2352 x 1568 pixels · 45-degree field of view
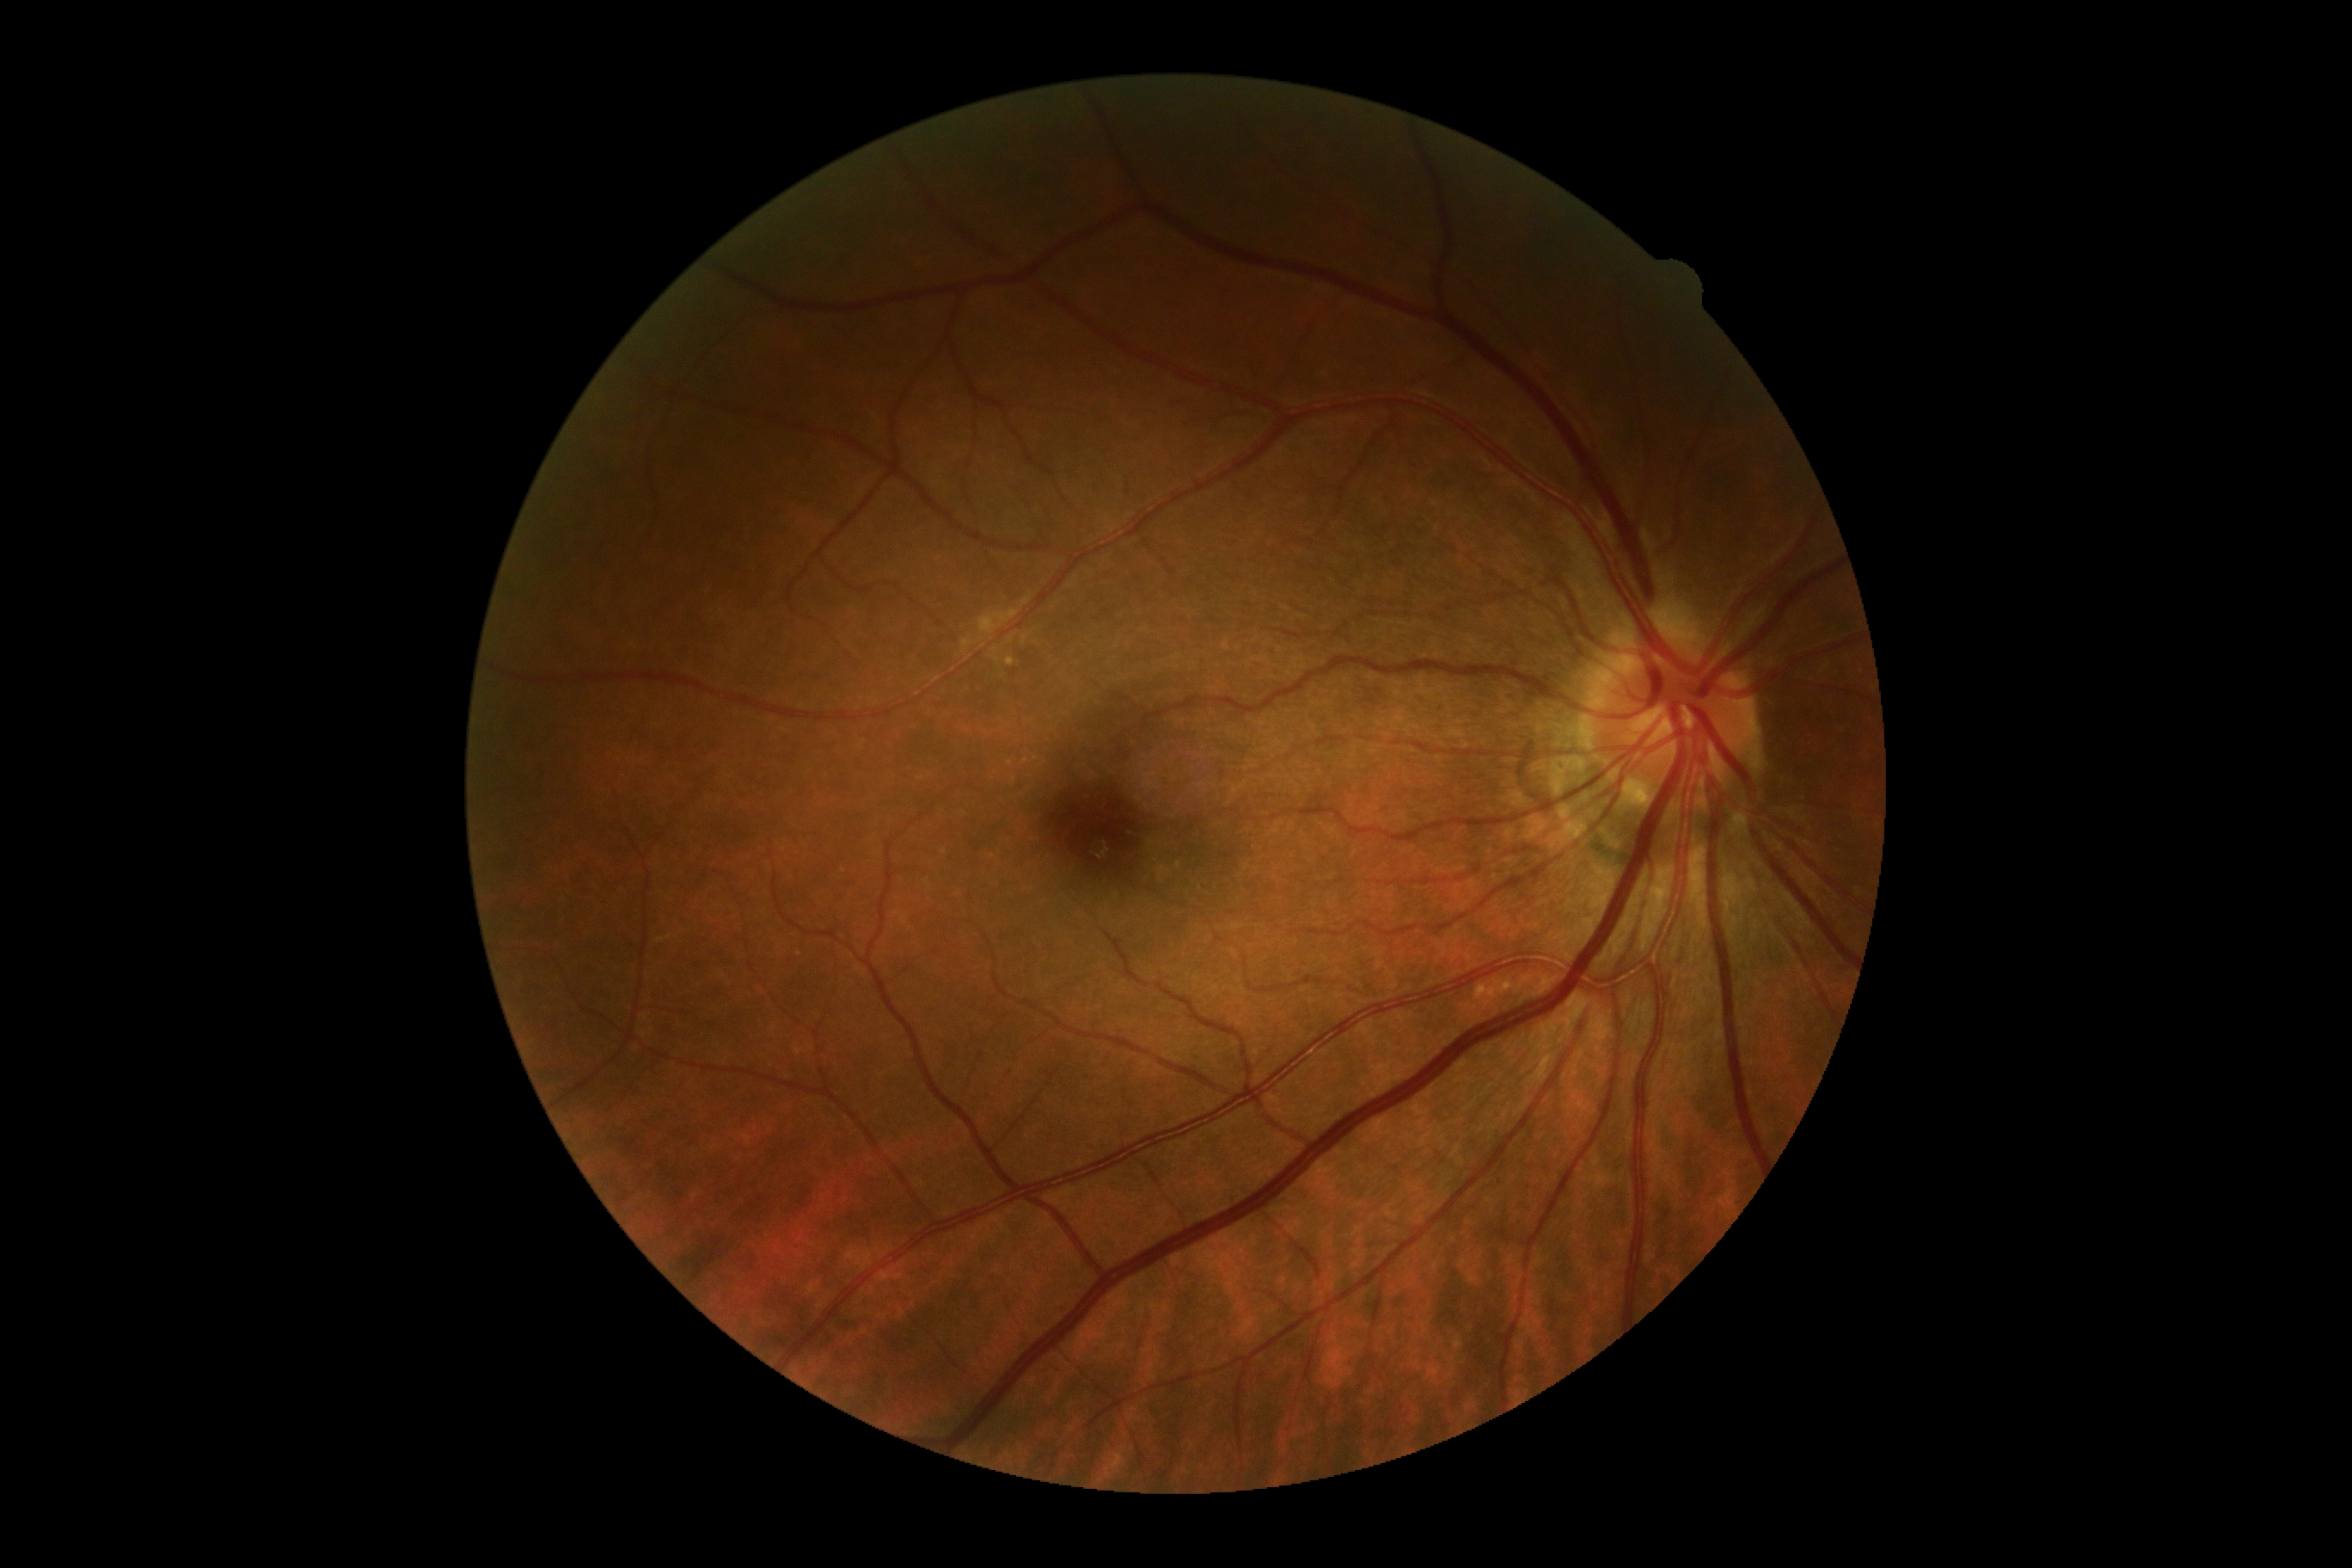

dr_impression: no signs of DR
dr_grade: grade 0